Optic nerve head photograph · camera: Topcon TRC — 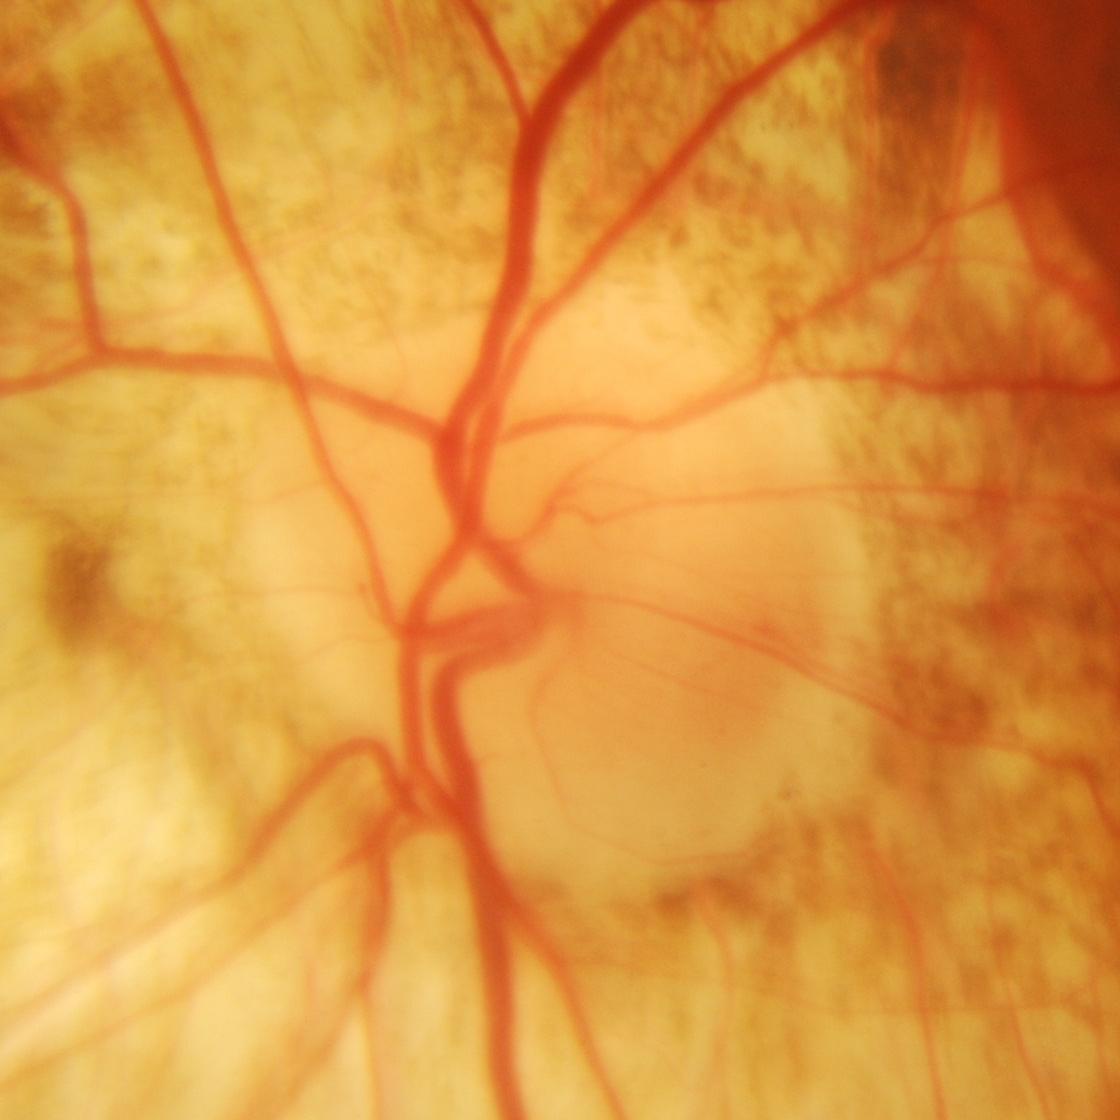
Demonstrates glaucoma.